Camera: Remidio Fundus on Phone (FOP) camera:
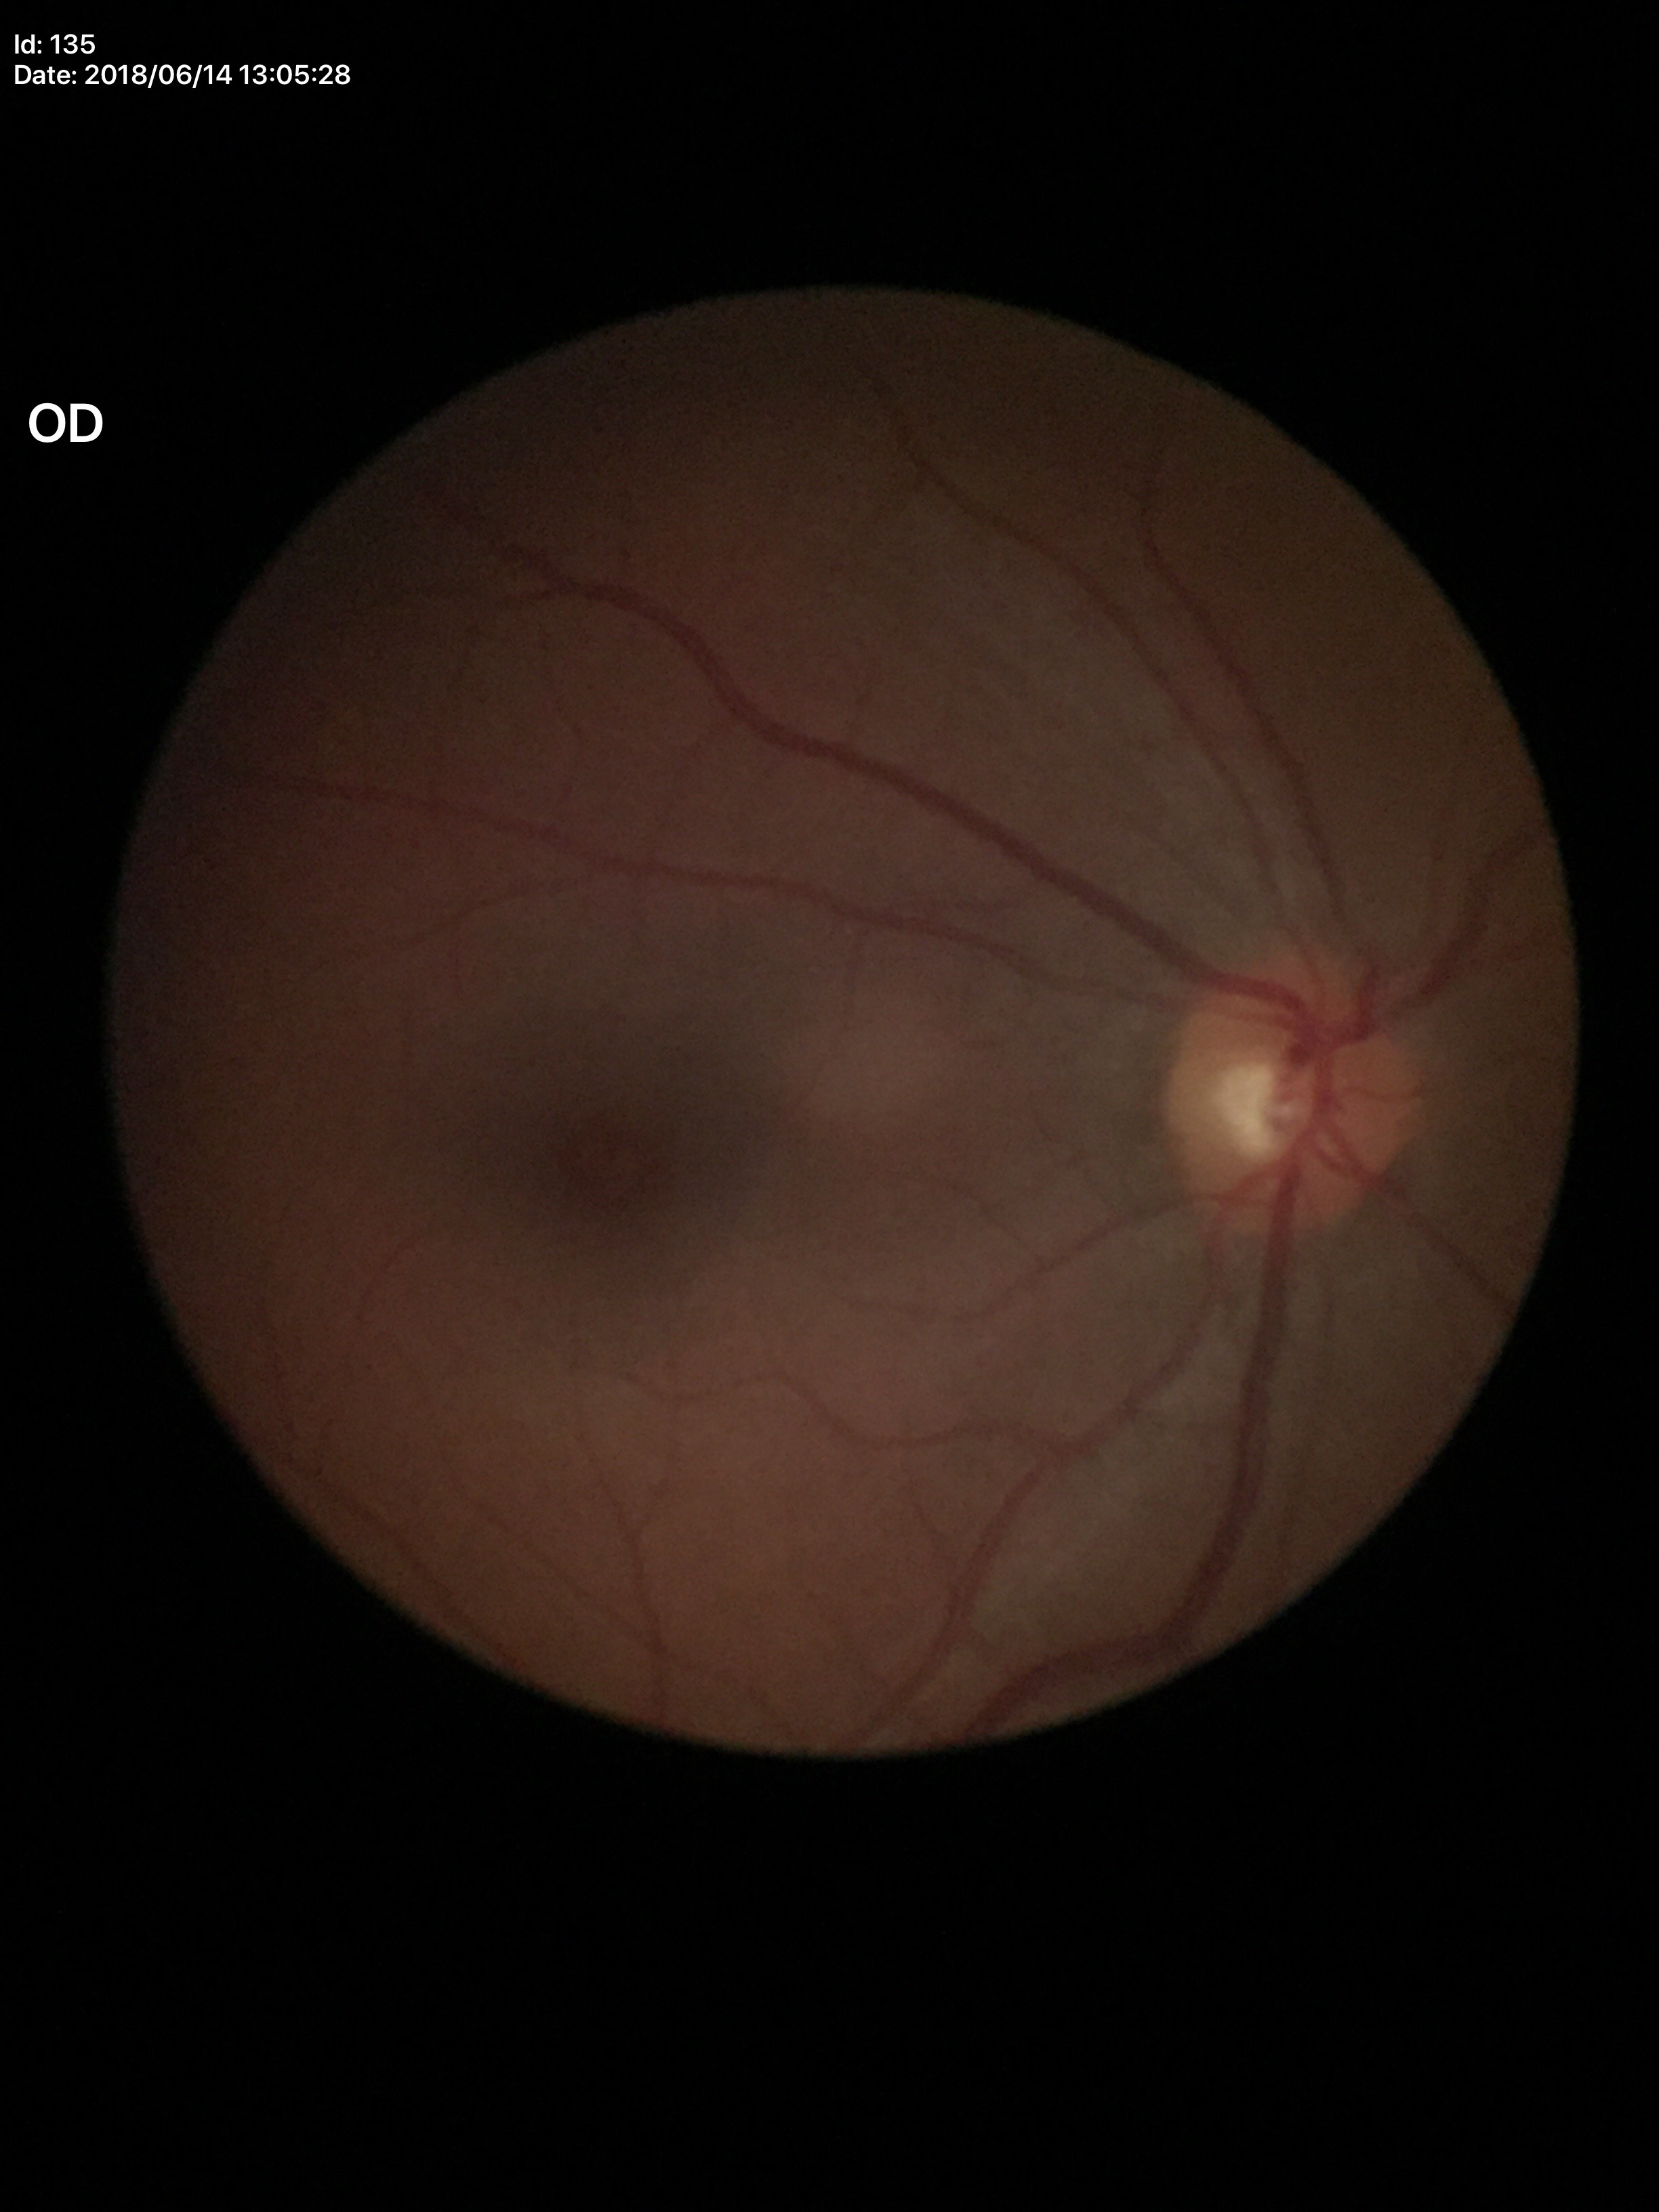 vertical cup-disc ratio: 0.48
Glaucoma impression: negative
area C/D ratio: 0.24